Retinal fundus photograph
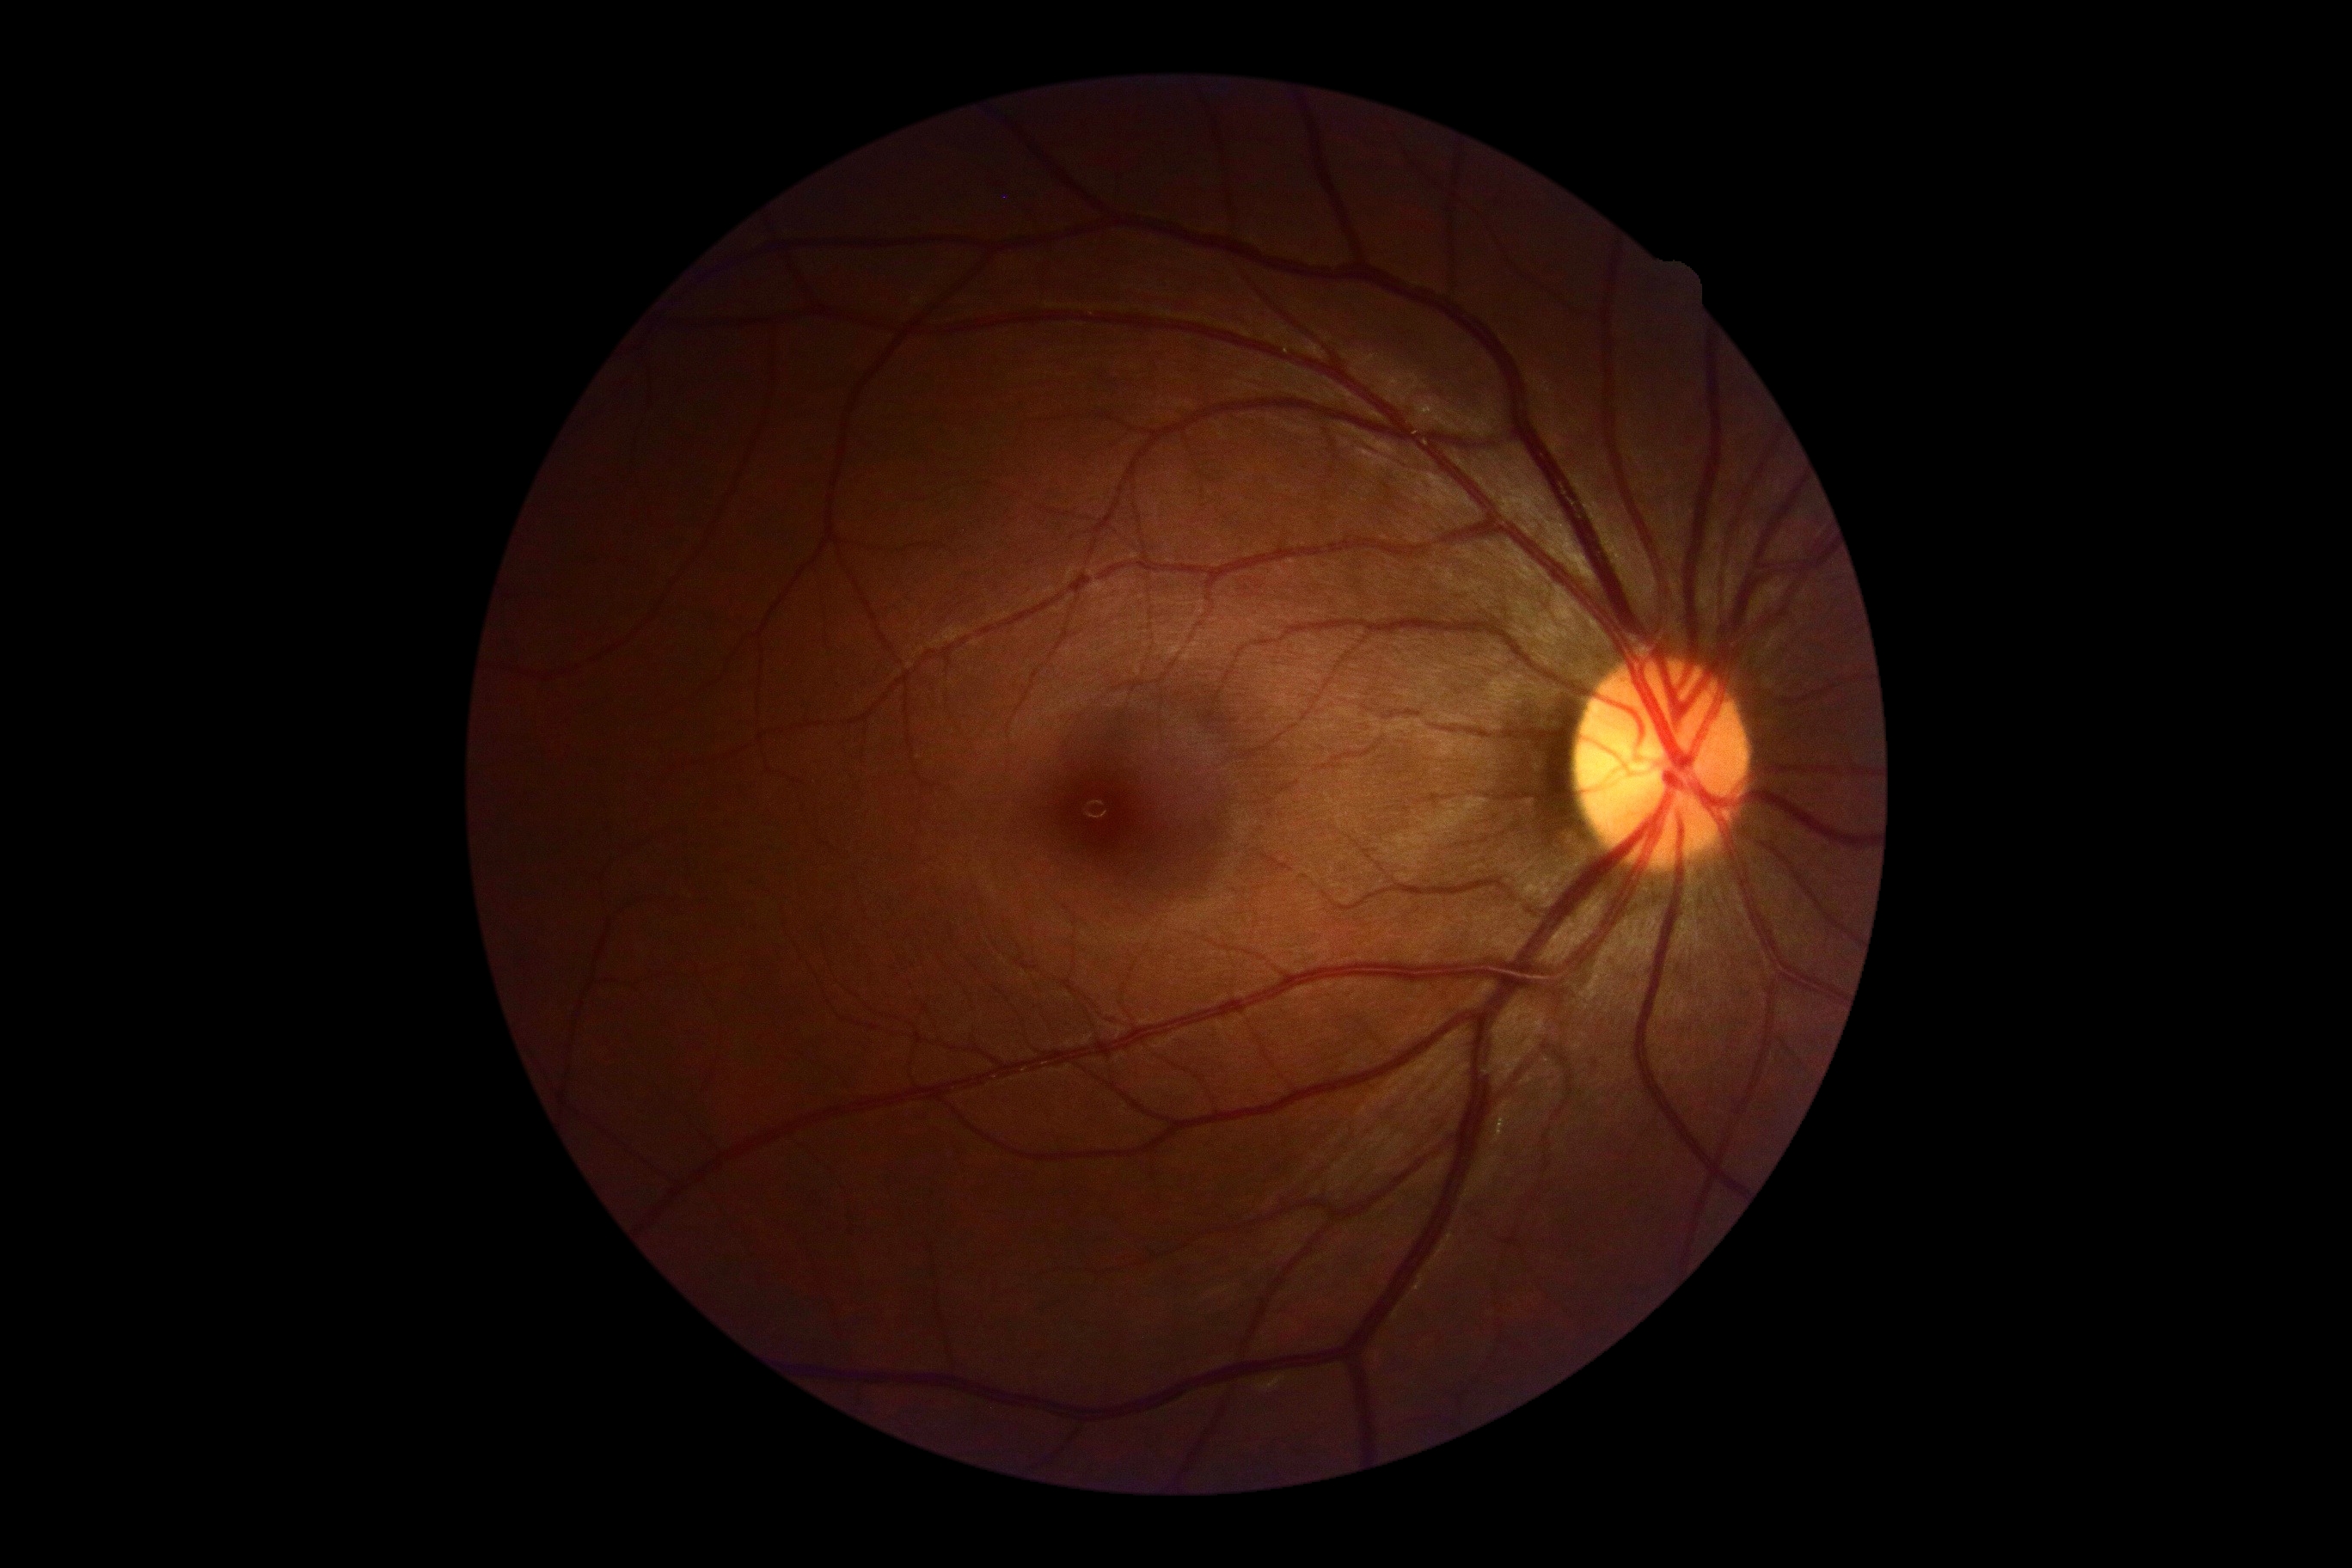
No apparent diabetic retinopathy.
Diabetic retinopathy severity: grade 0.